RetCam wide-field infant fundus image: 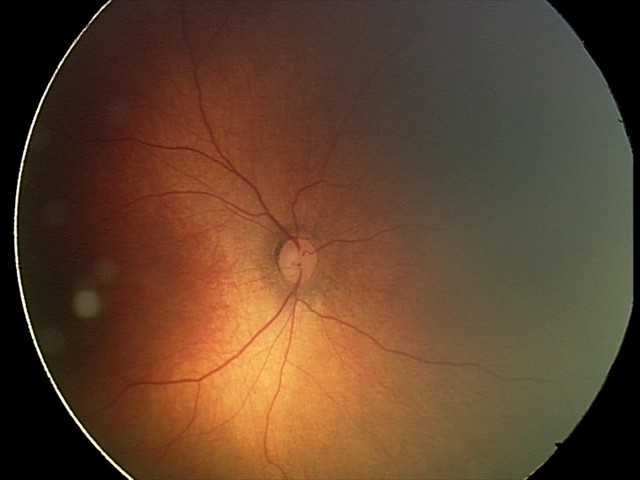
Screening examination with no abnormal retinal findings.